Without pupil dilation; 45° FOV:
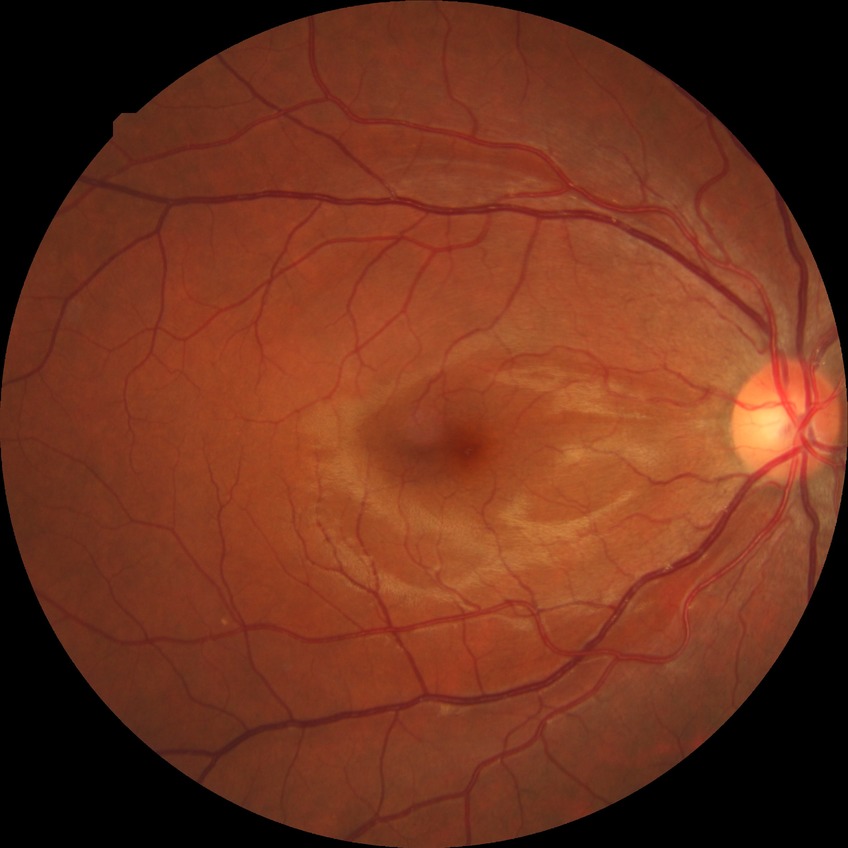

Diabetic retinopathy (DR): no diabetic retinopathy (NDR).